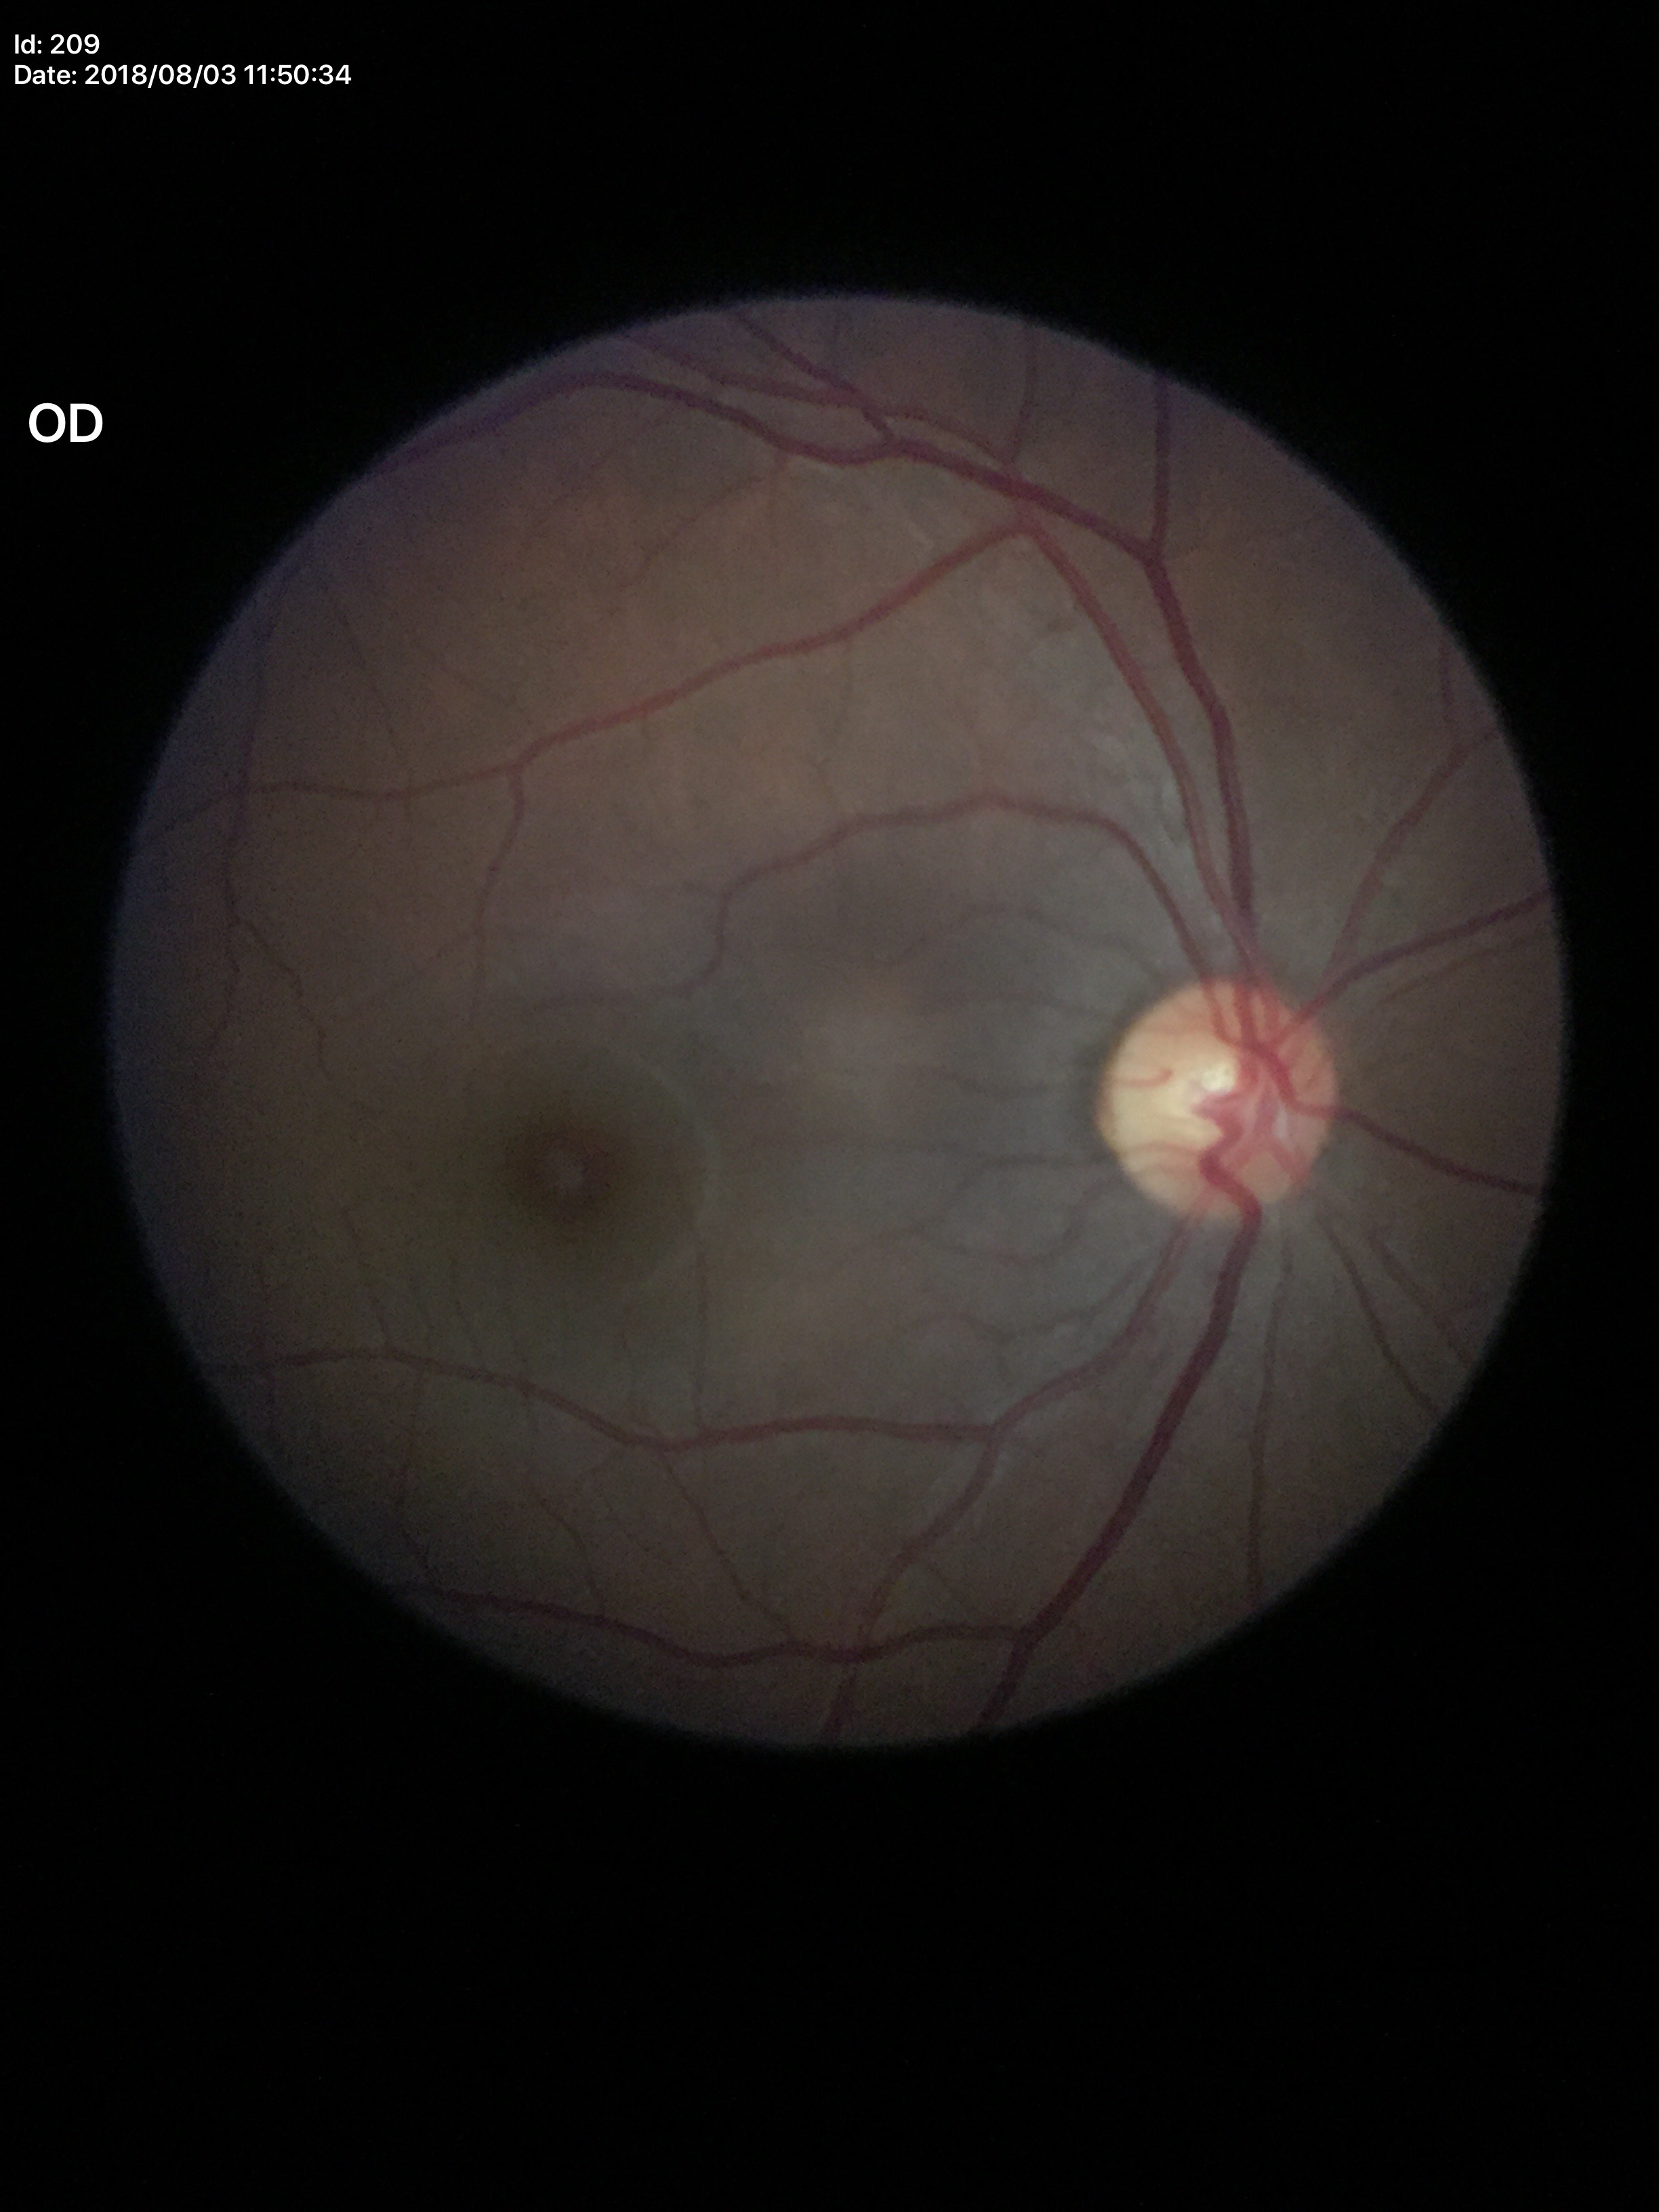
Glaucoma evaluation: no suspicious findings. Vertical cup-to-disc ratio (VCDR) of 0.53. Horizontal CDR (HCDR): 0.51.